Image size 1932x1910; CFP.
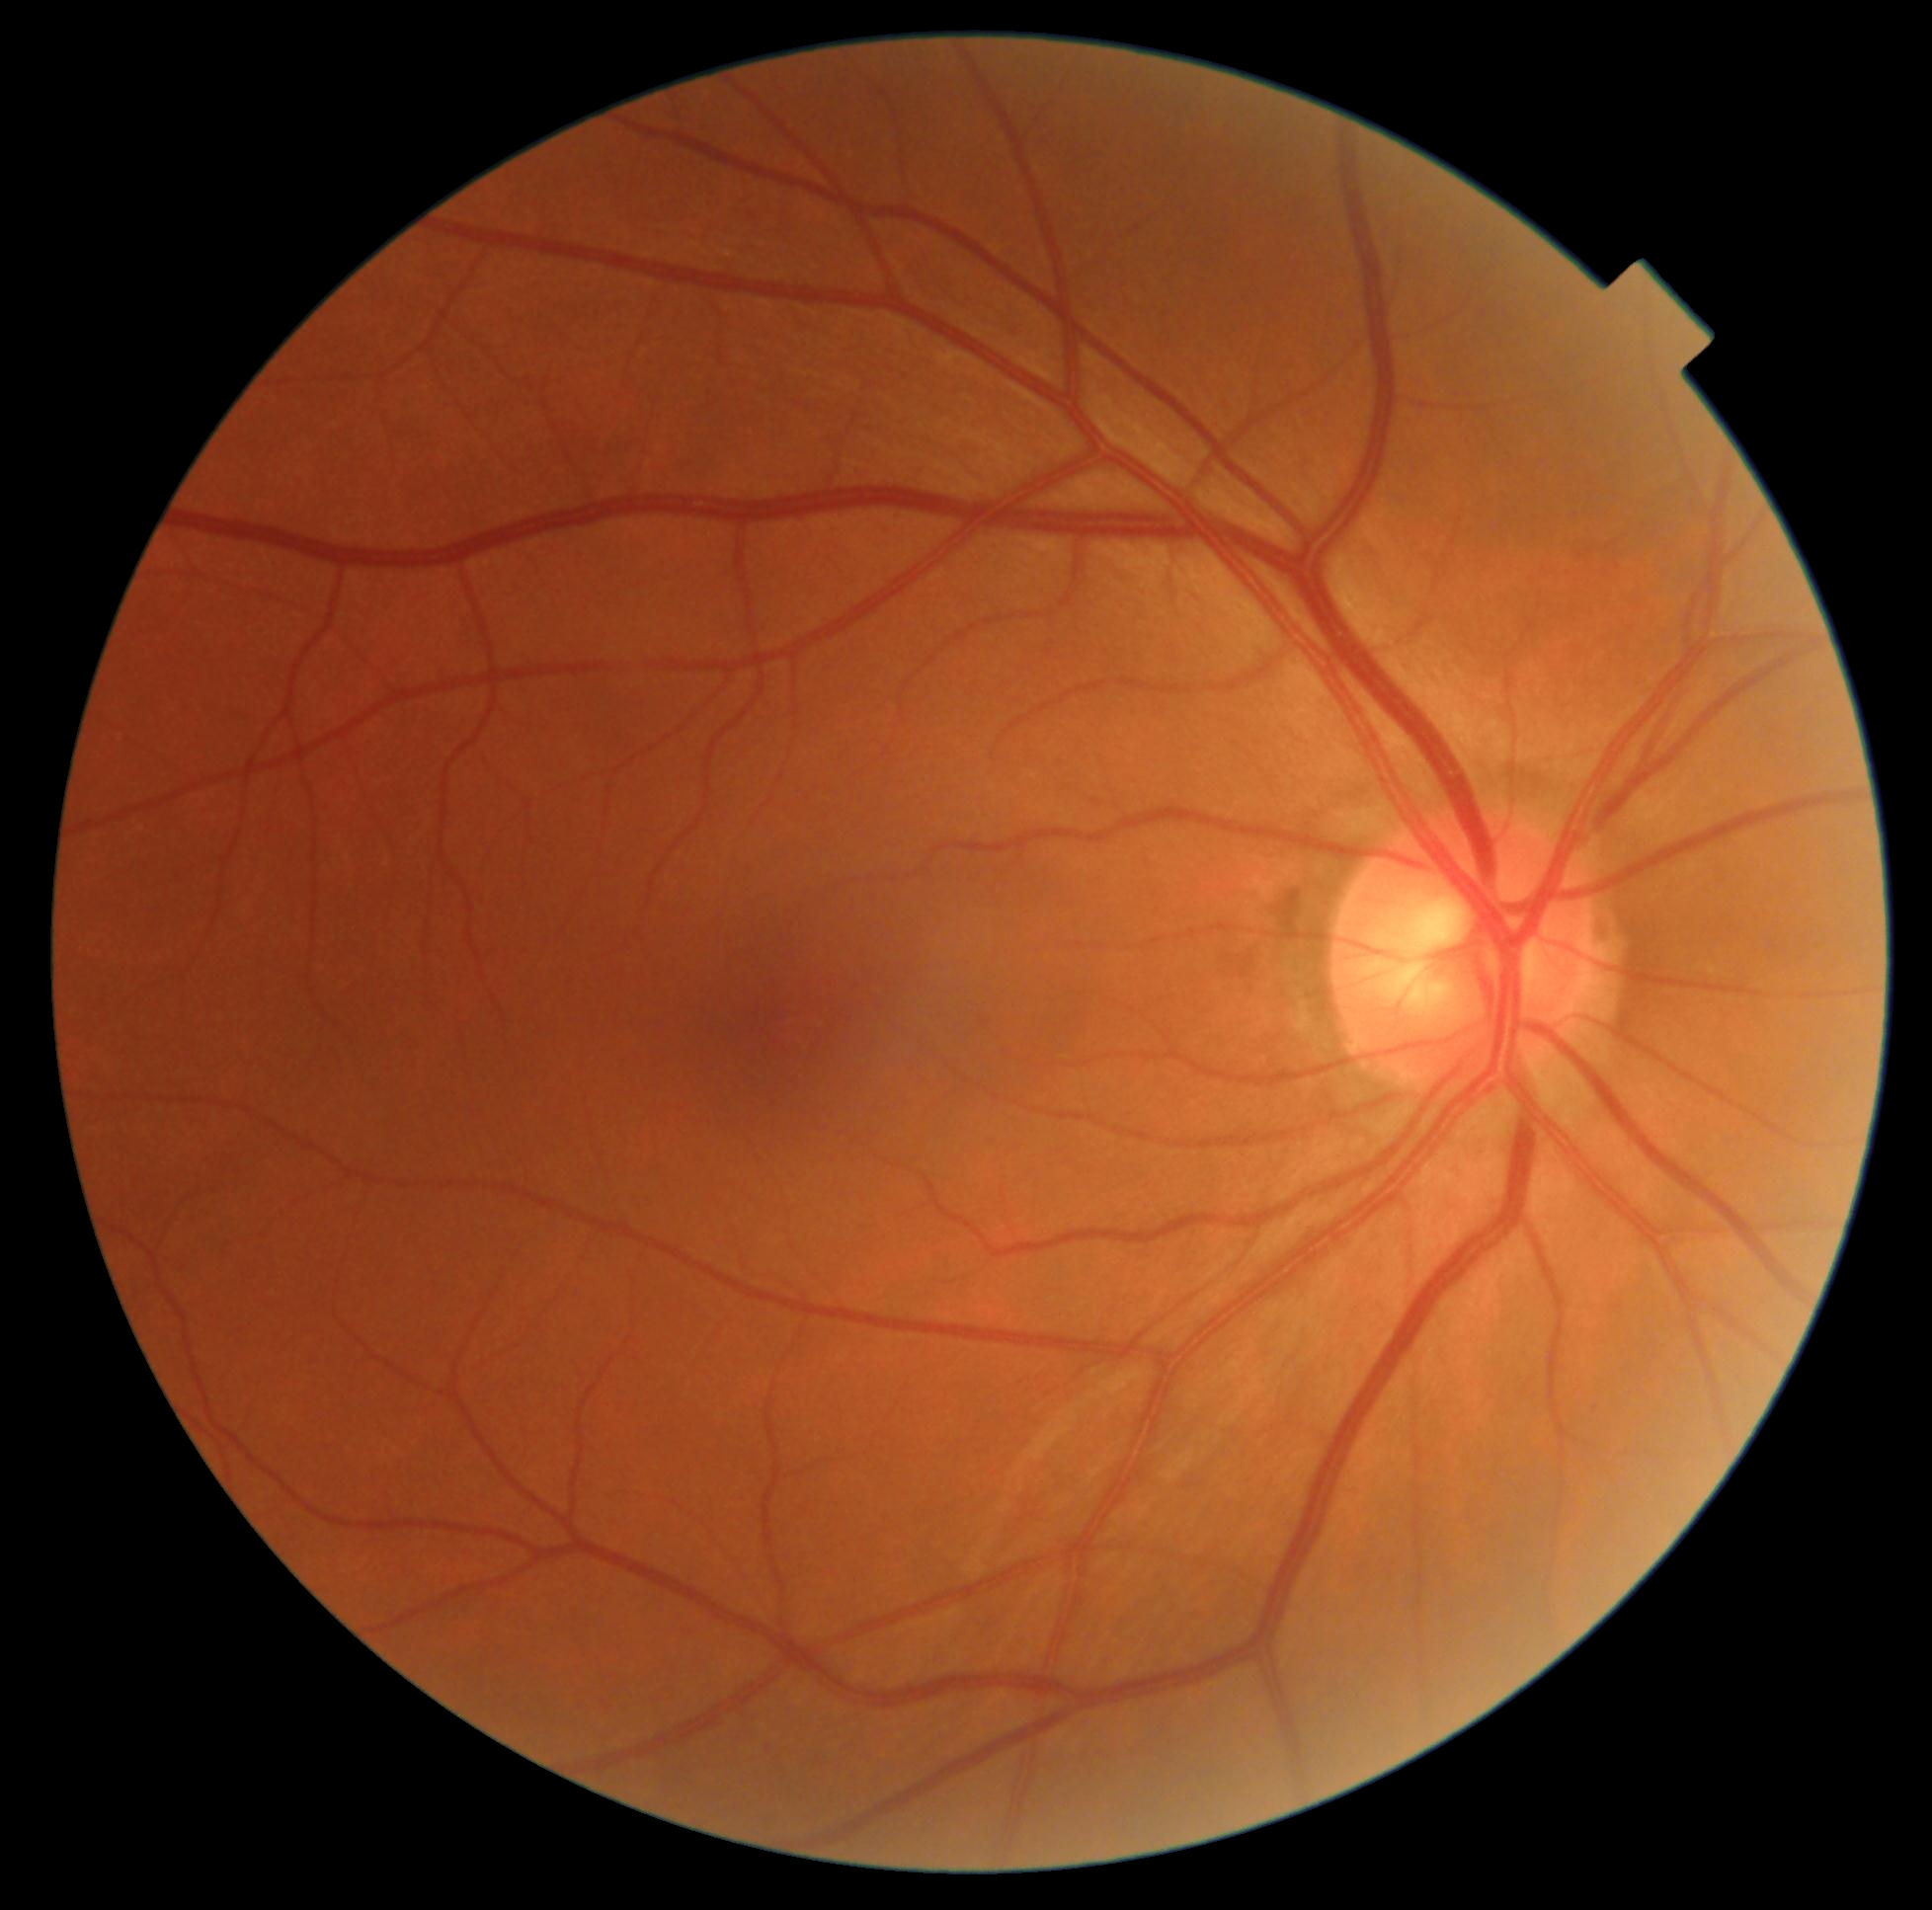
- DR stage — grade 0
- DR impression — negative for DR